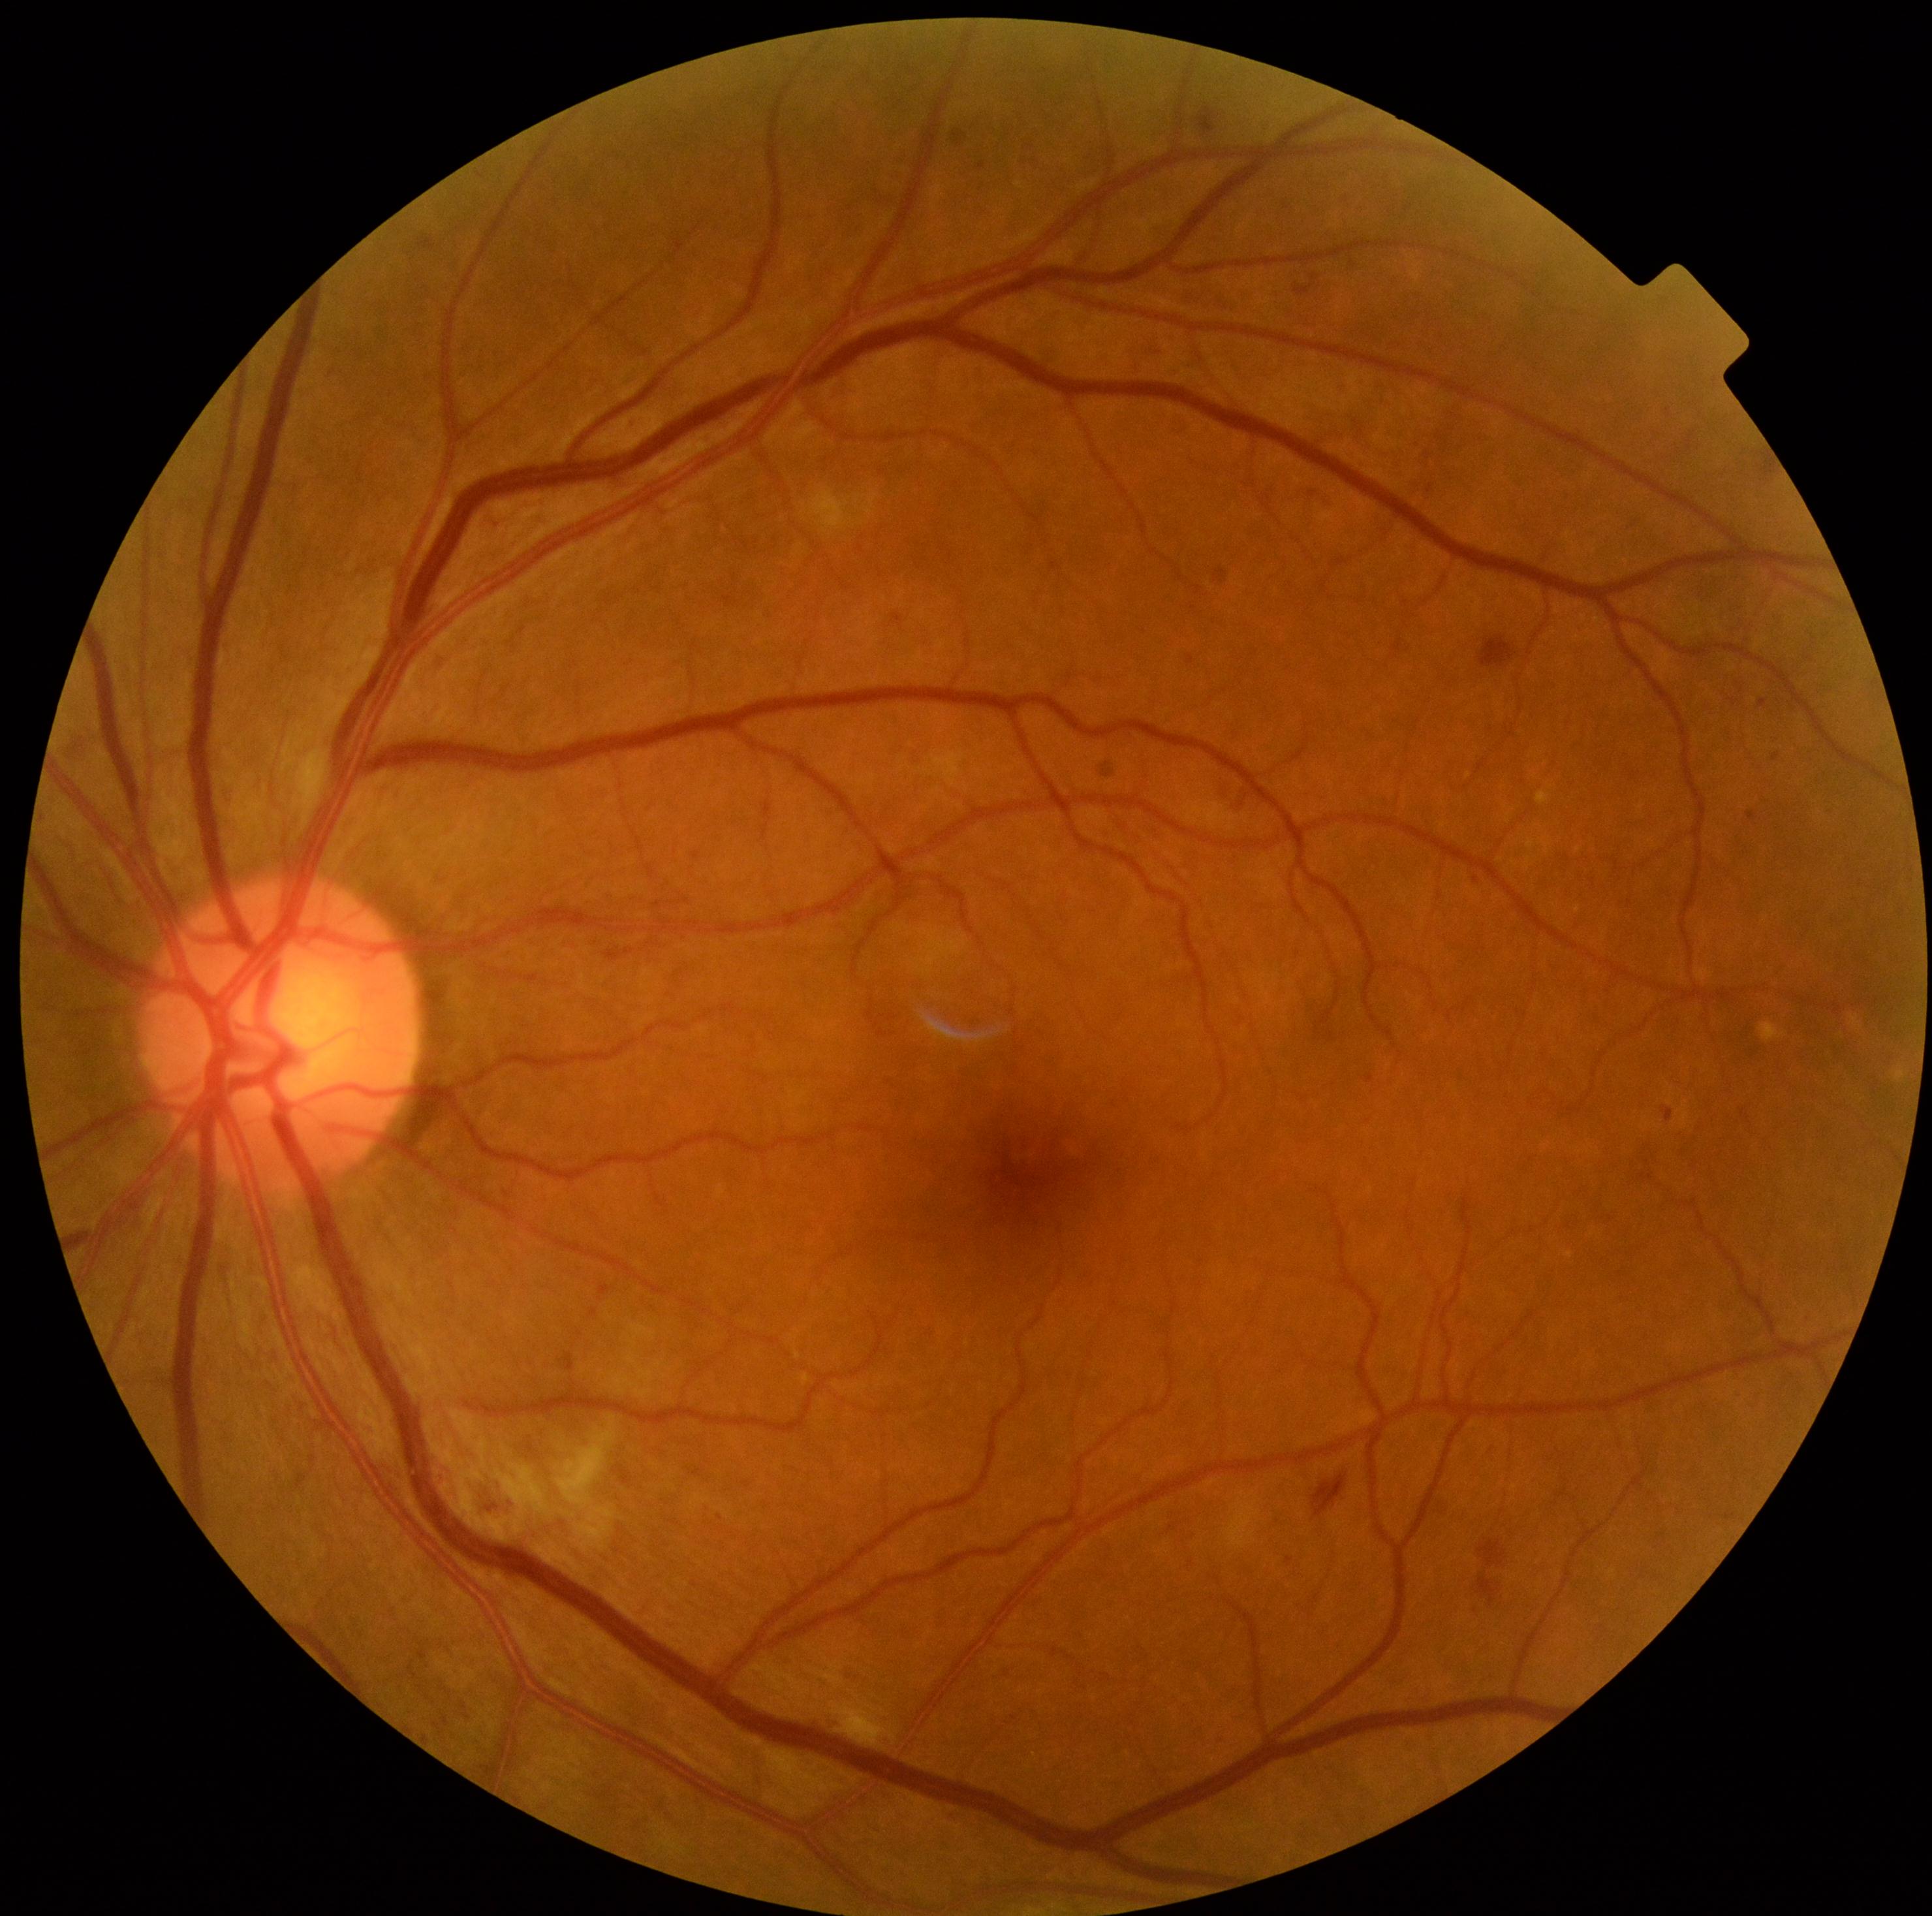 Diabetic retinopathy severity: 2. Disease class: non-proliferative diabetic retinopathy.